Fundus photo:
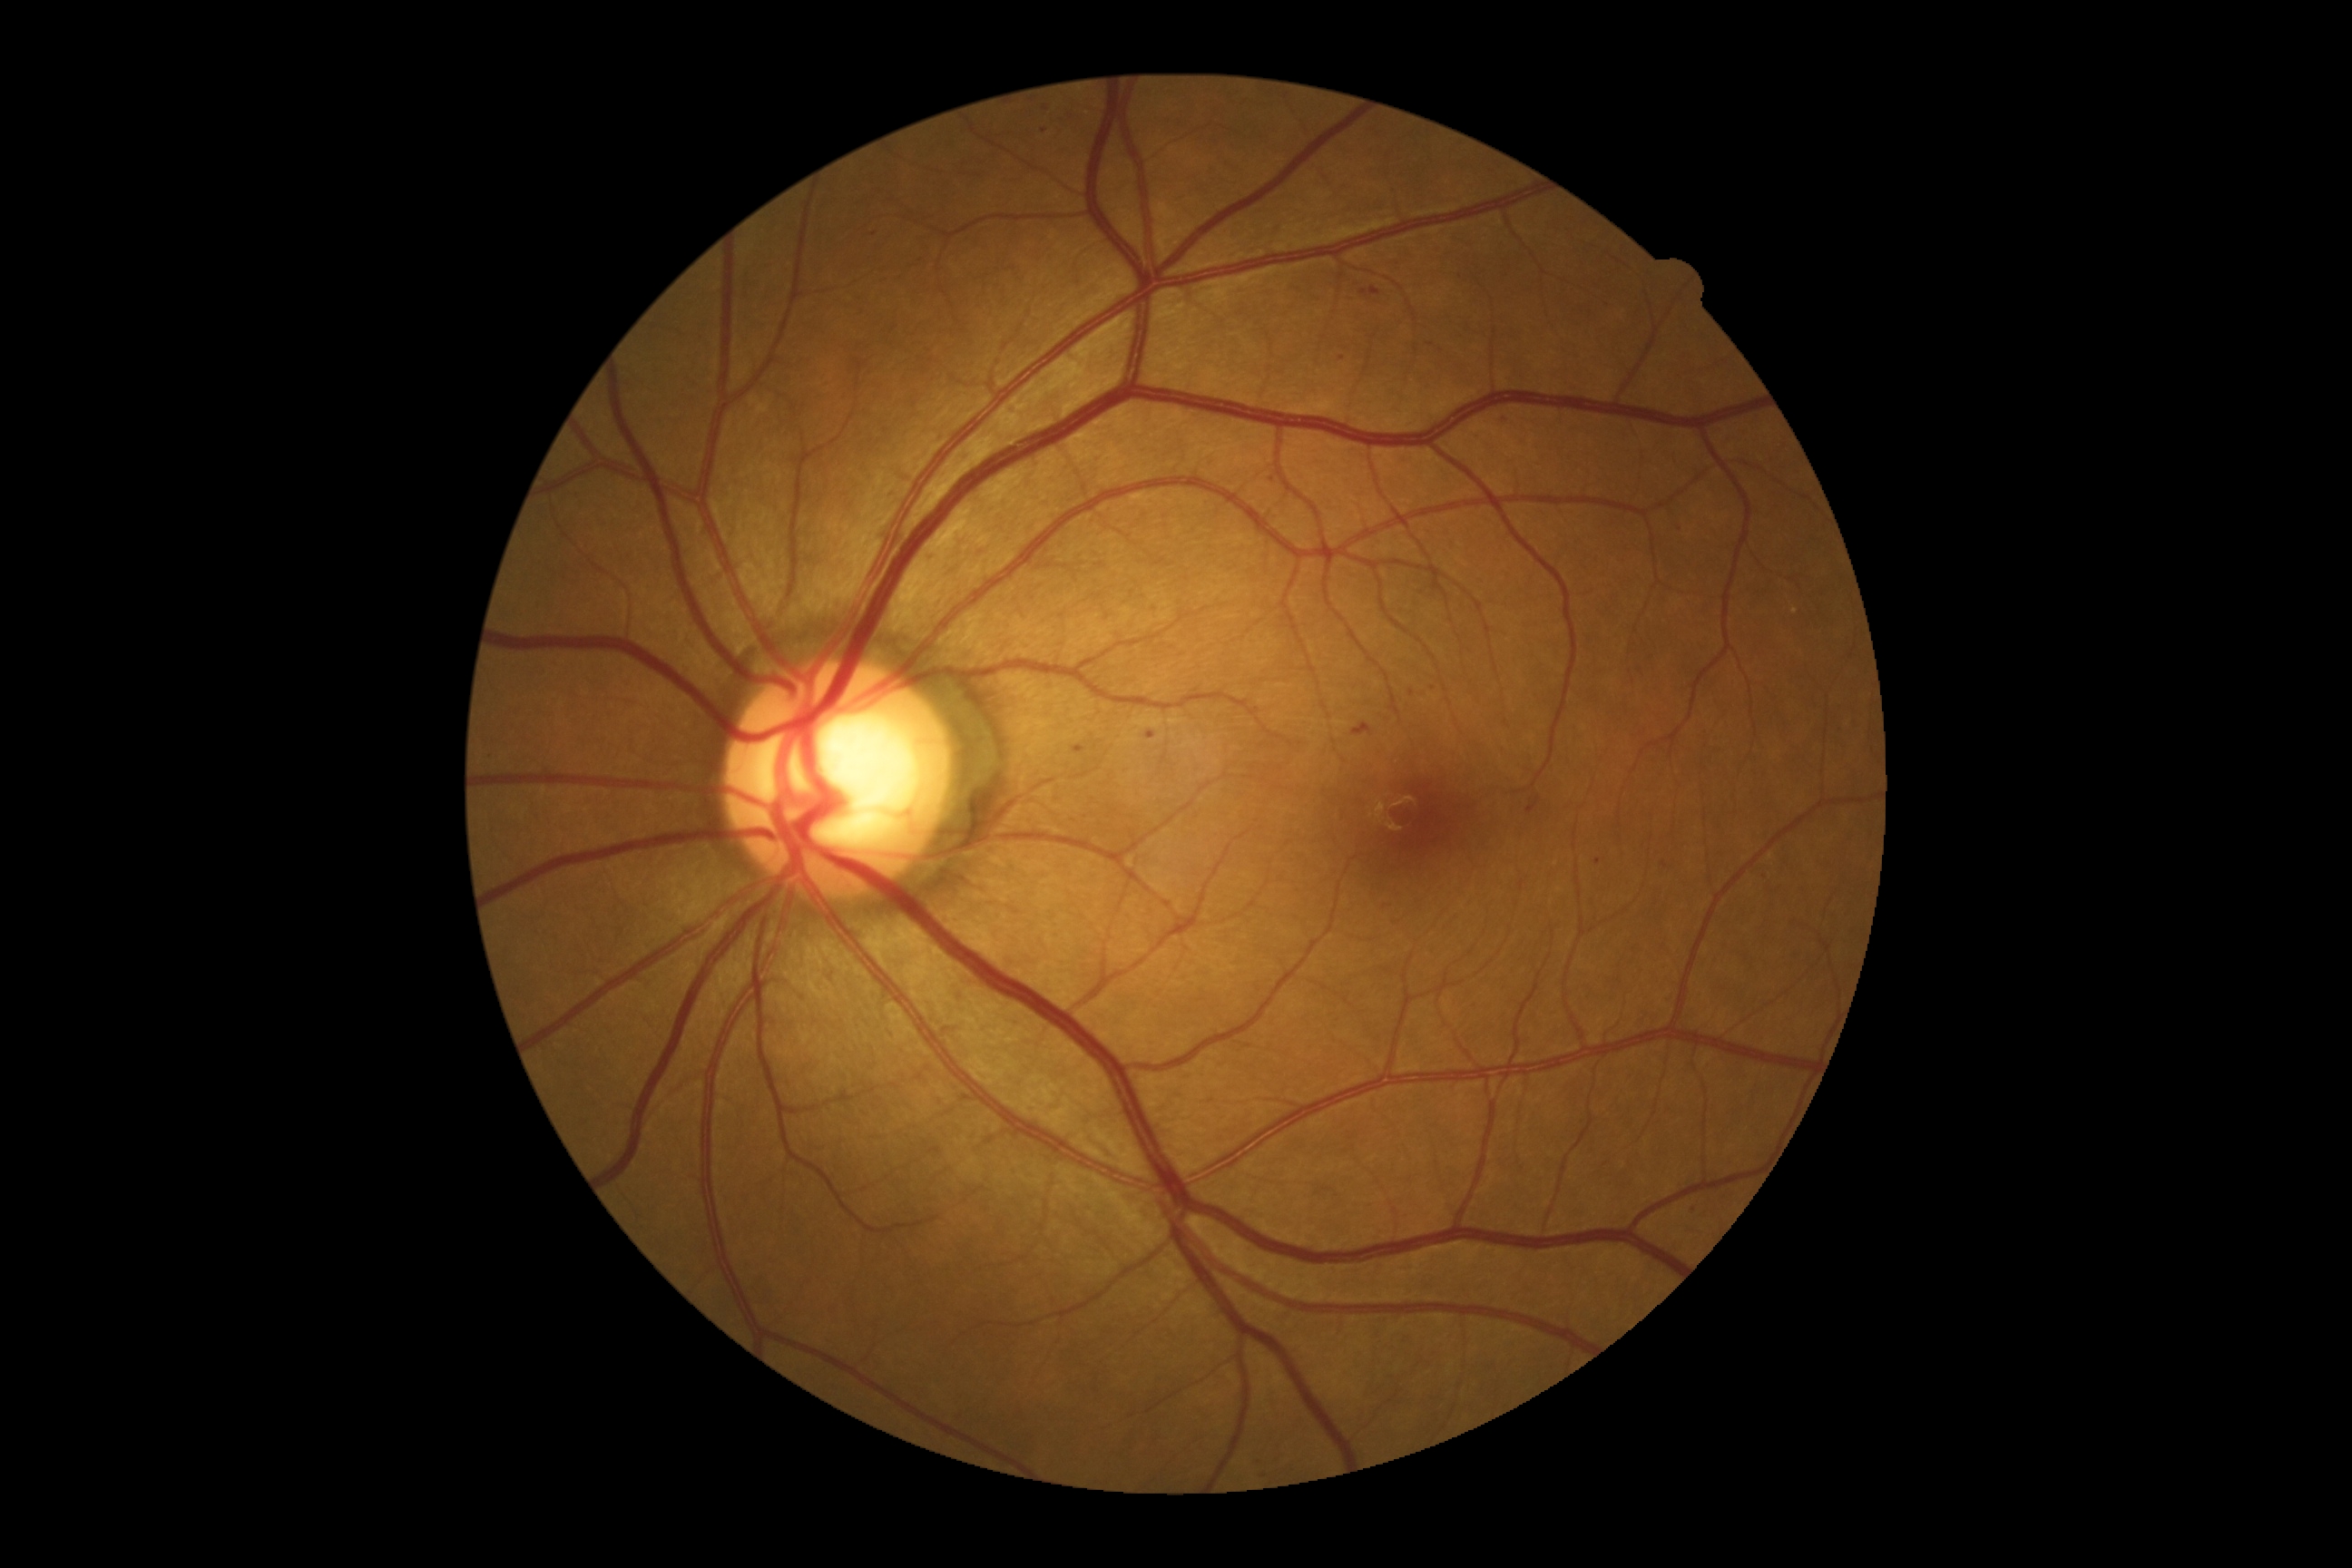 DR class: non-proliferative diabetic retinopathy. Diabetic retinopathy is moderate NPDR (grade 2).